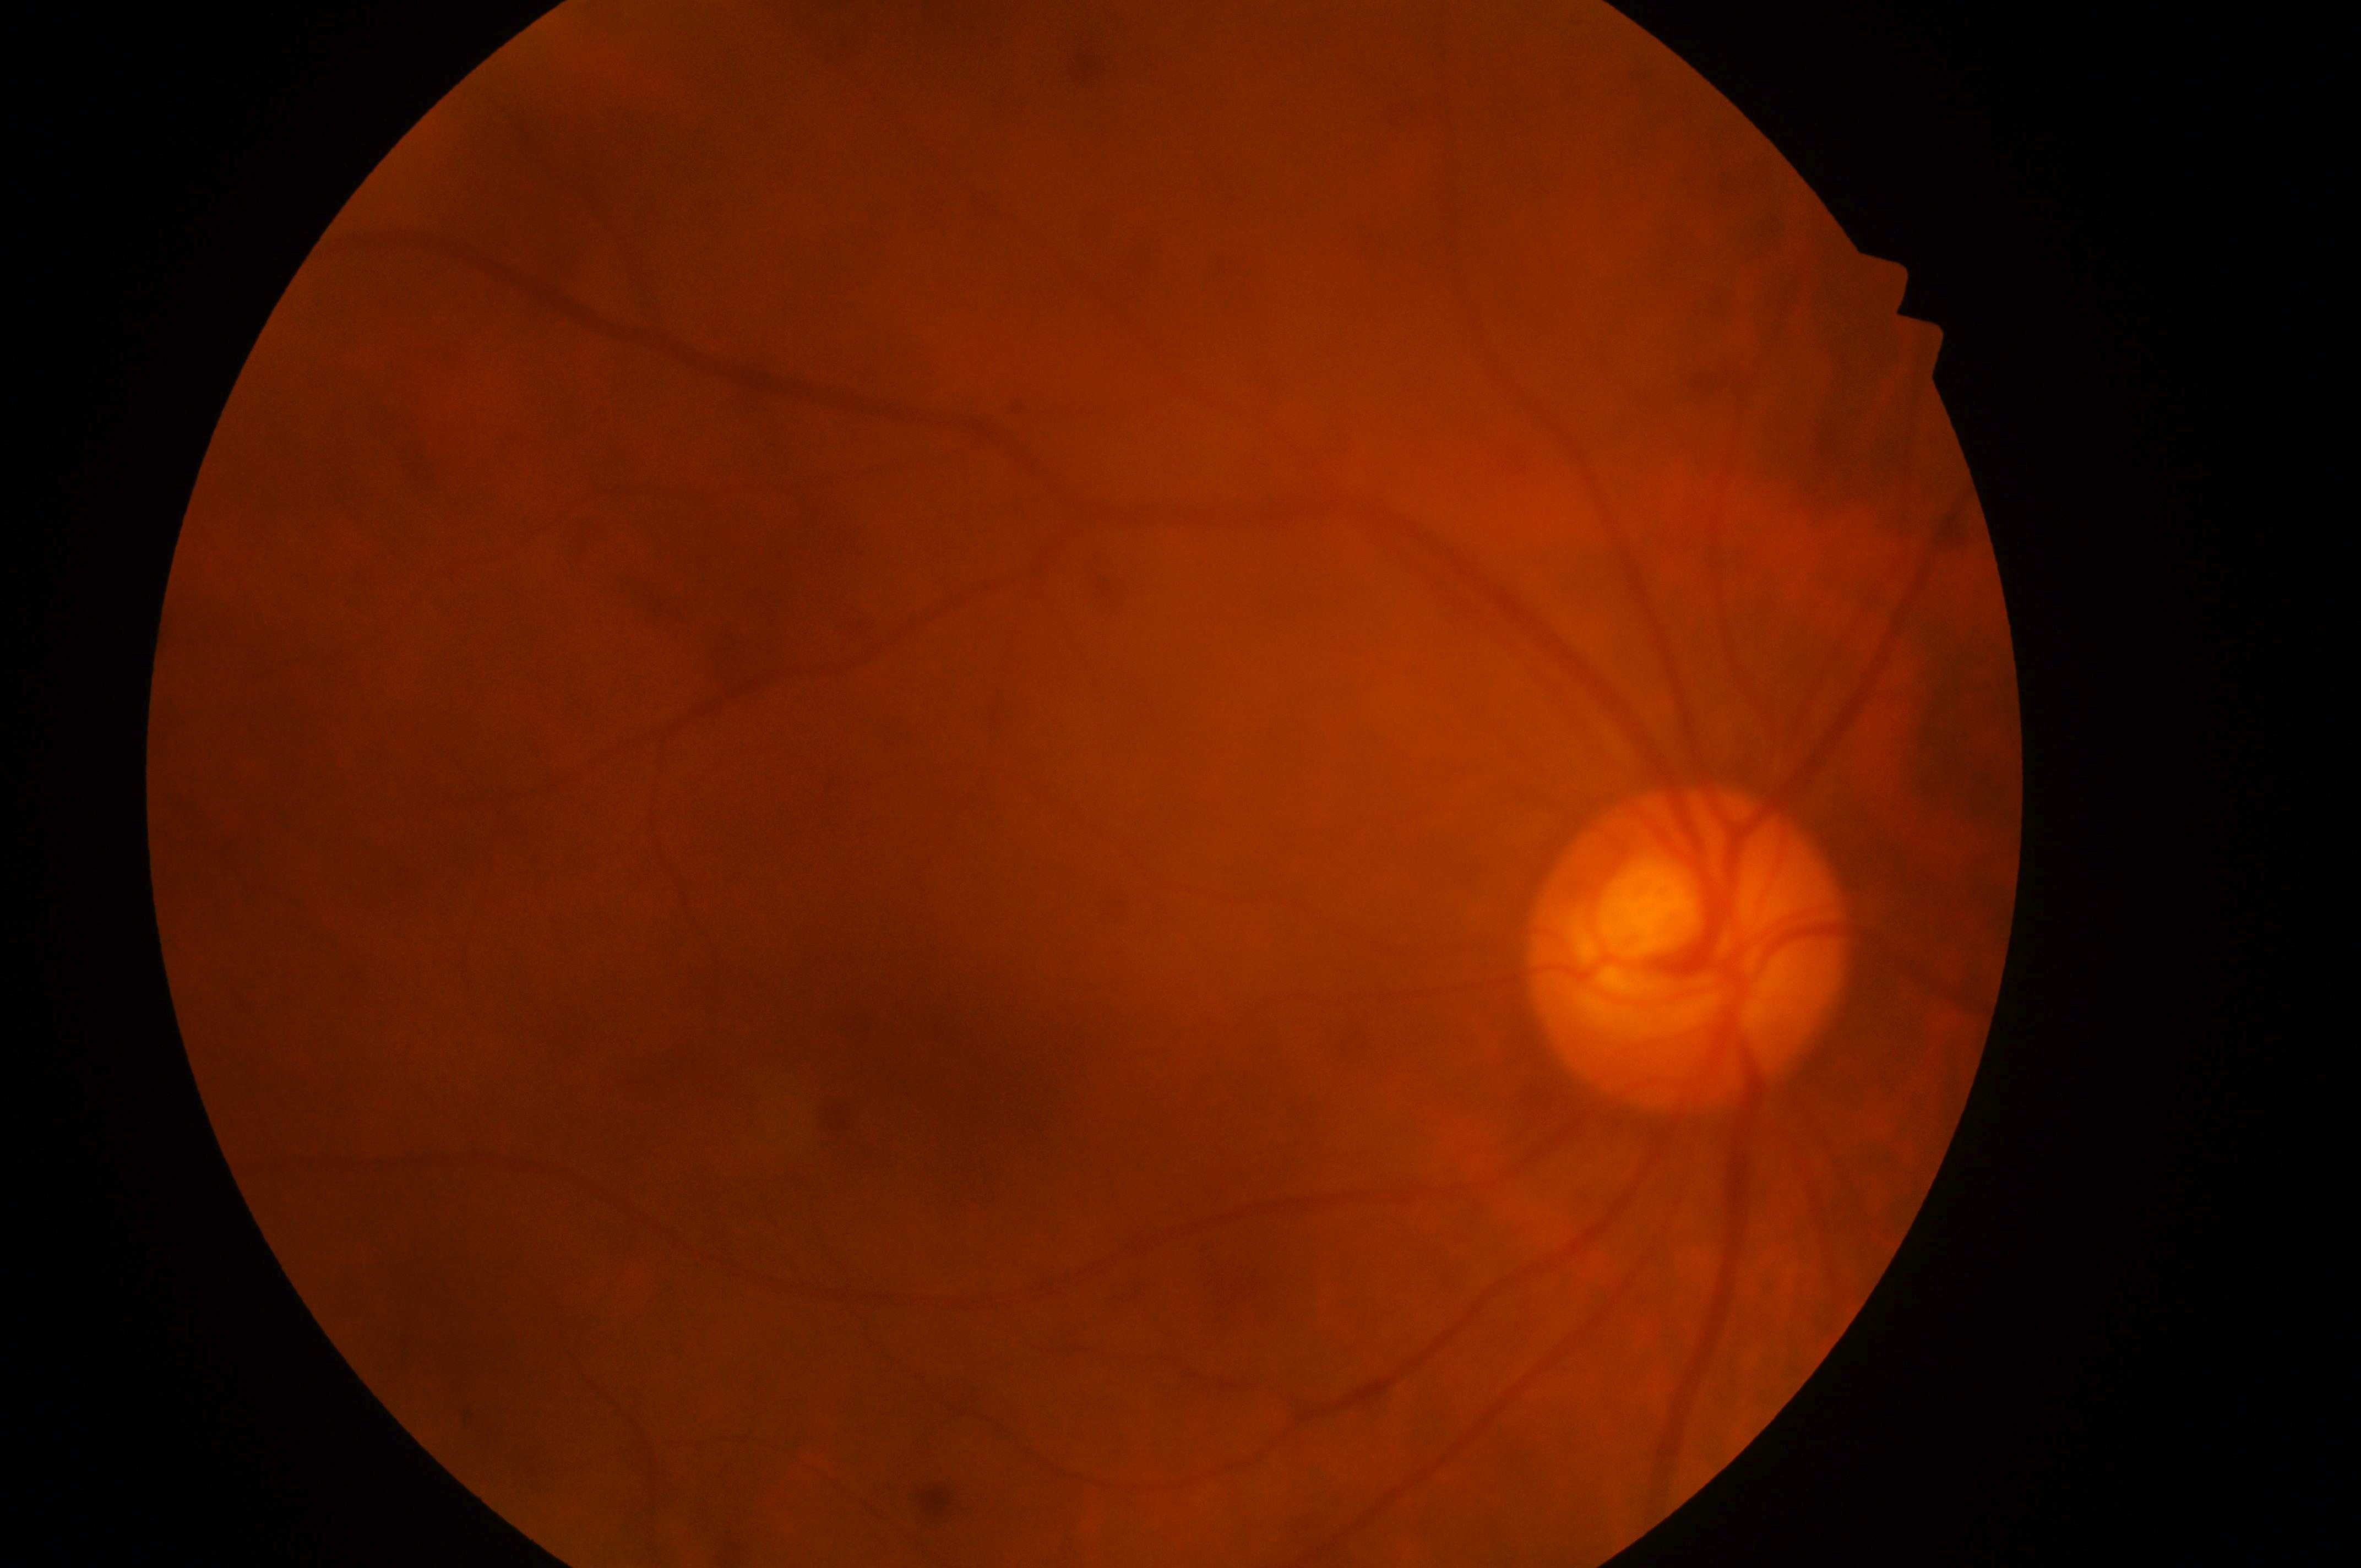 Imaged eye: right. The macula center is at [944, 1093]. DME grade is 0. DR stage is grade 0. Optic disc: [1687, 967].